Color fundus photograph: 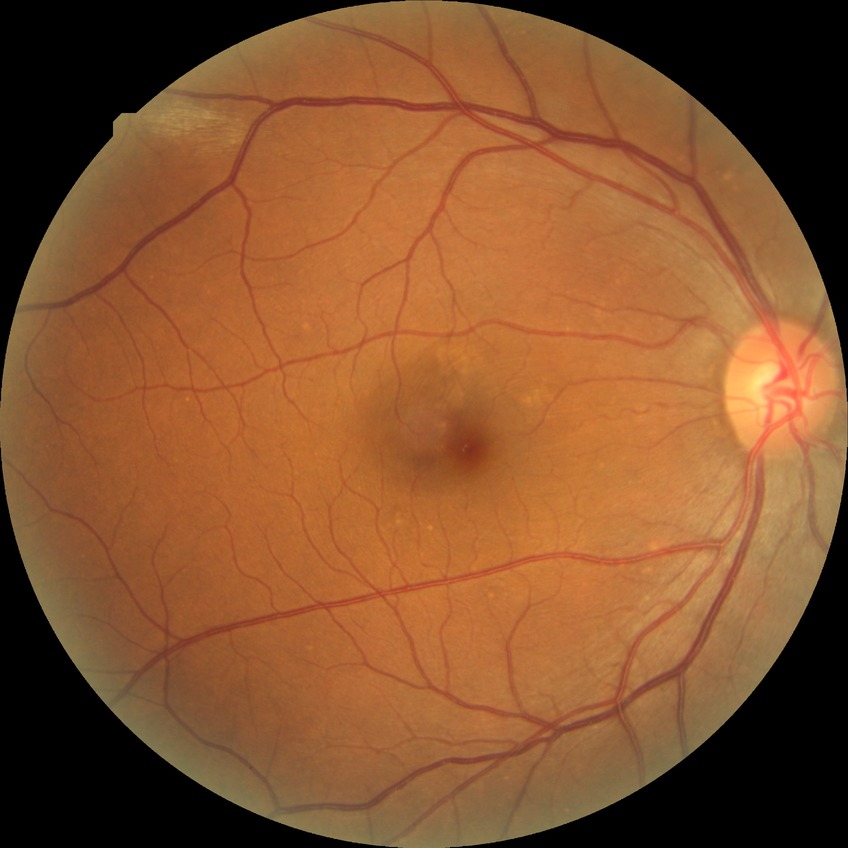
Davis grade: NDR.